Fundus photo. NIDEK AFC-230 fundus camera: 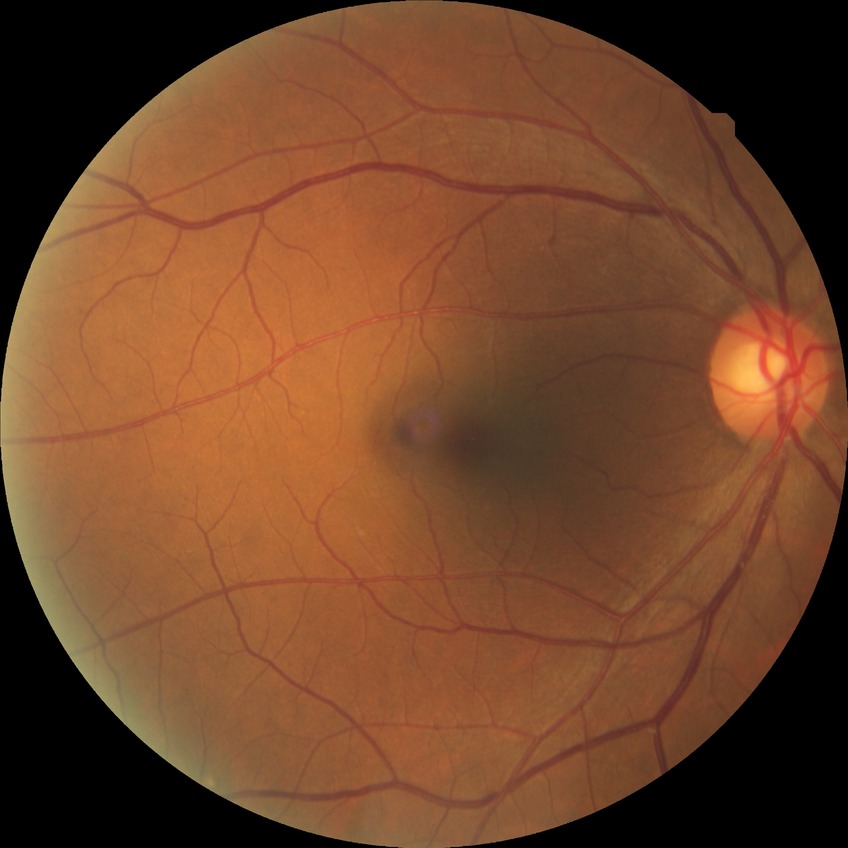

Assessment:
- DR class — non-proliferative diabetic retinopathy
- diabetic retinopathy (DR) — simple diabetic retinopathy (SDR)